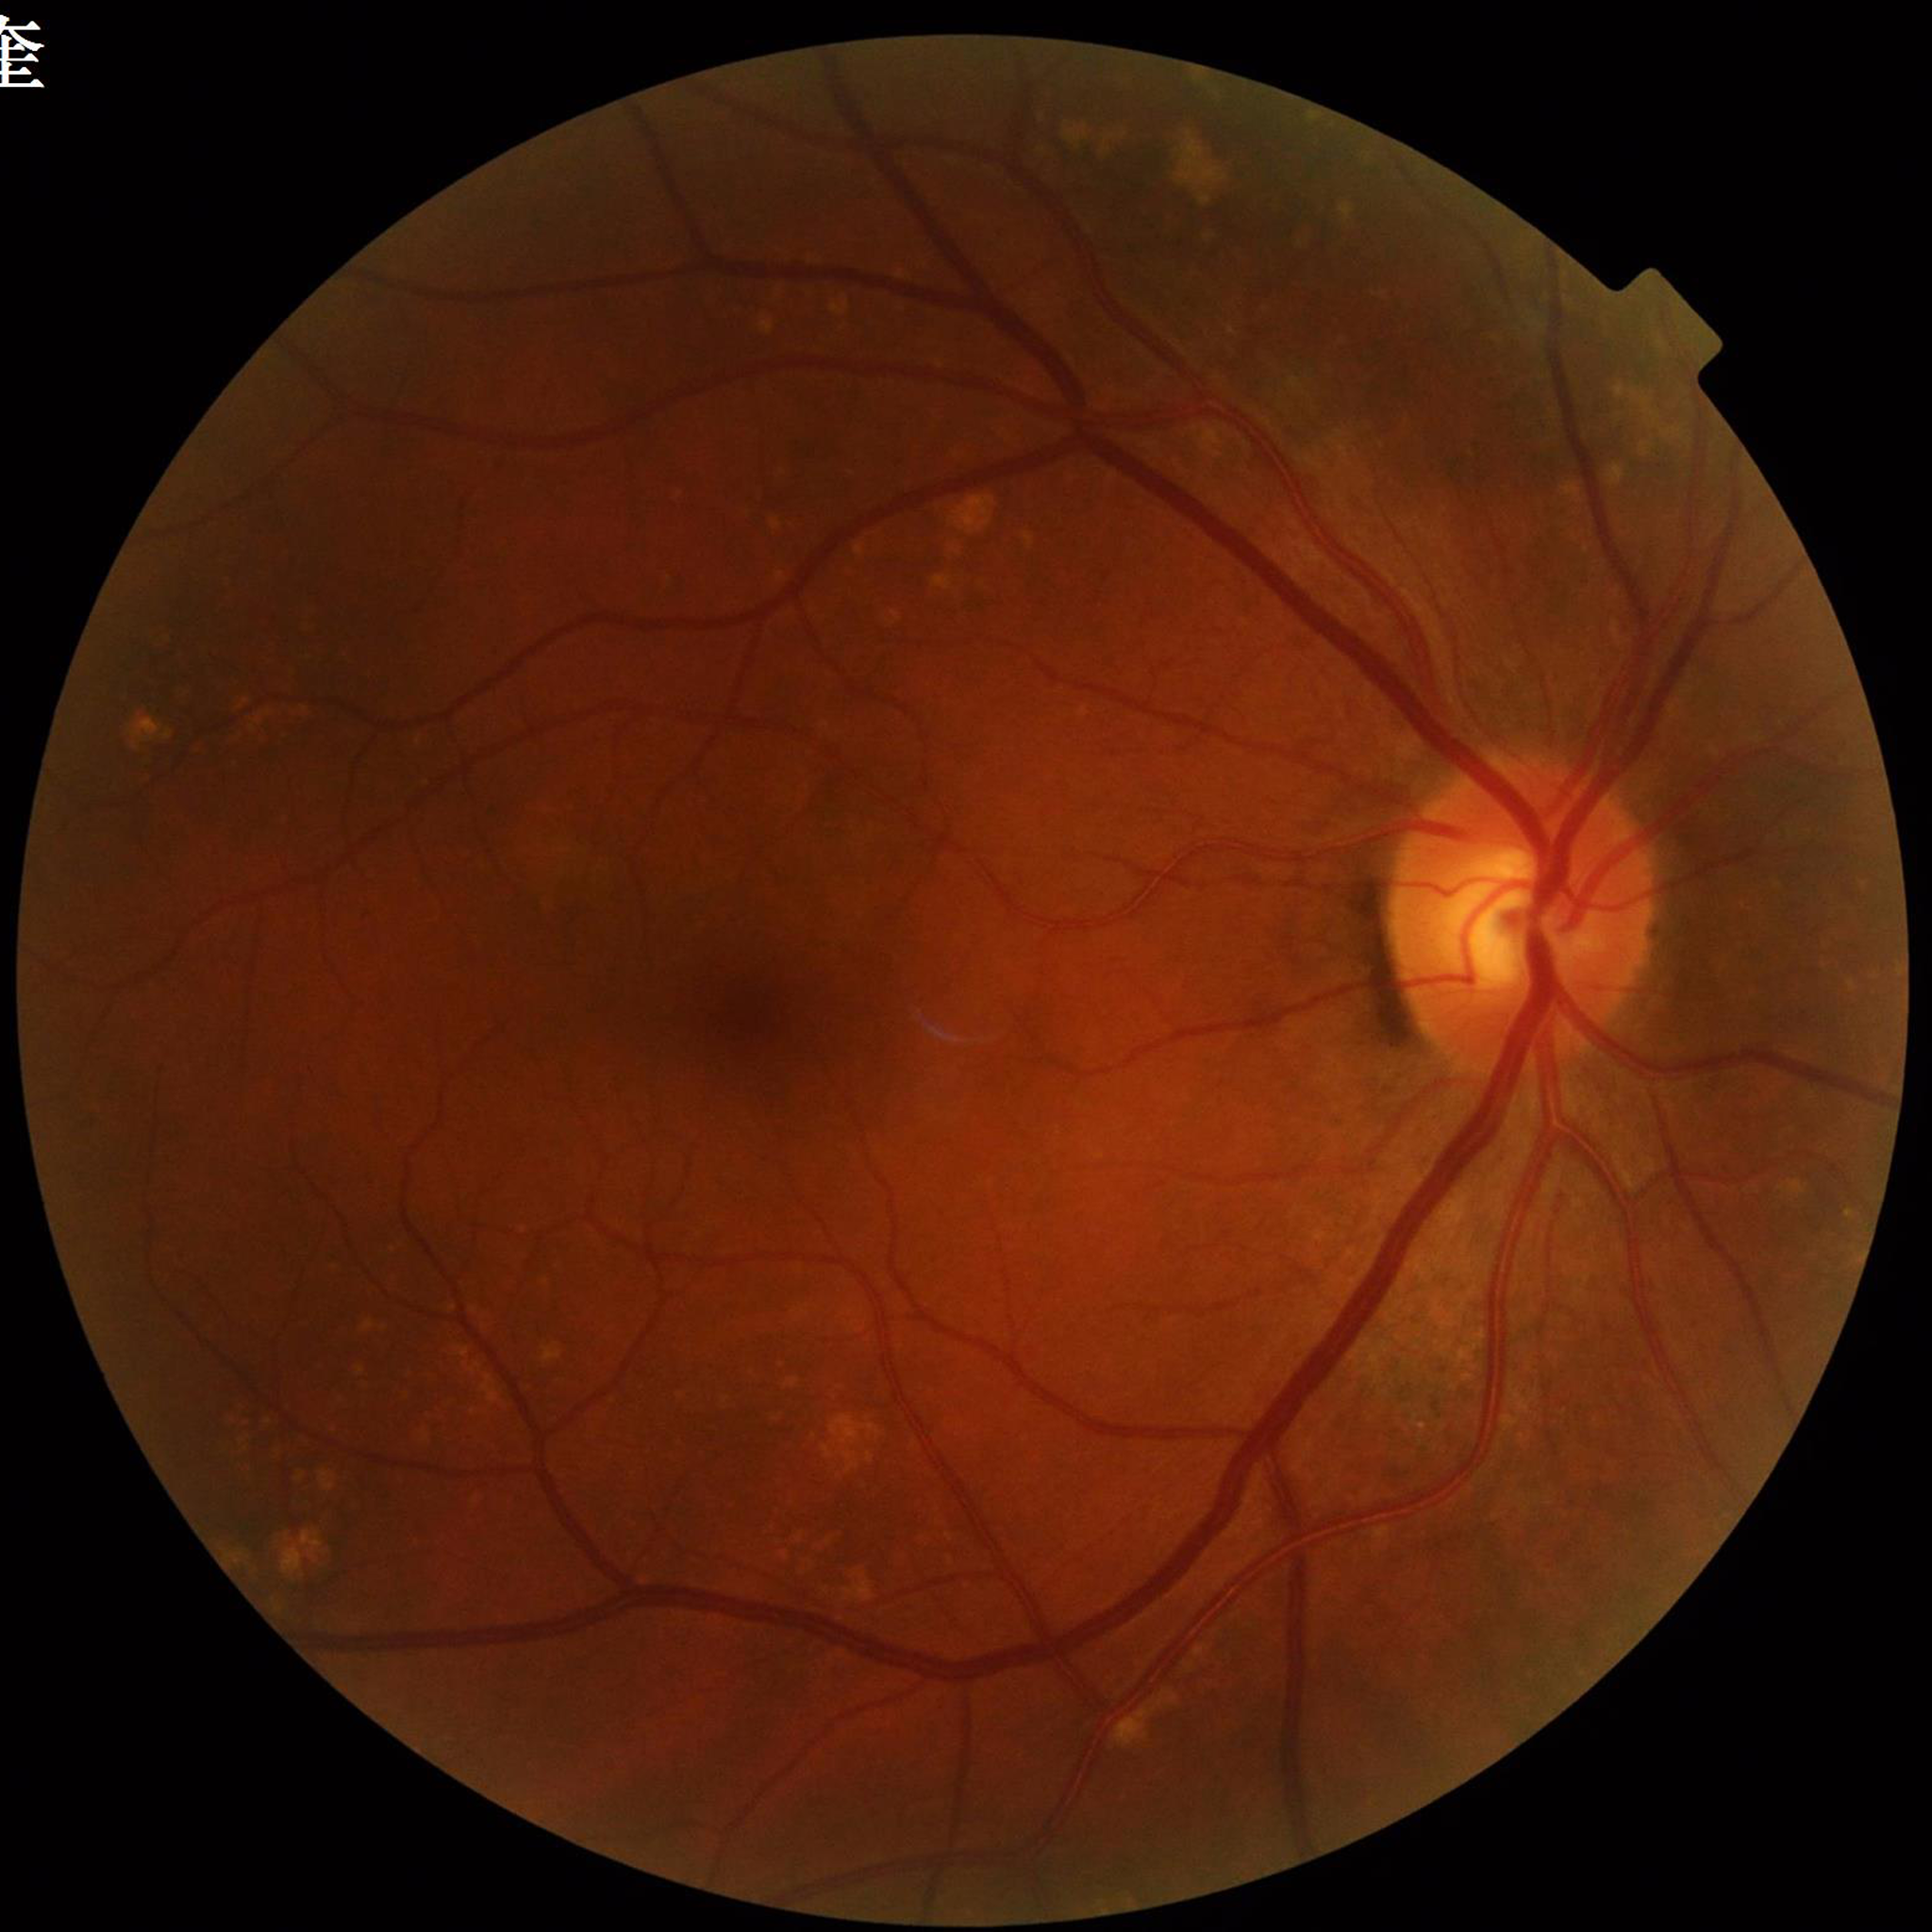
Condition: diabetic retinopathy (DR).